Graded on the modified Davis scale, fundus photo — 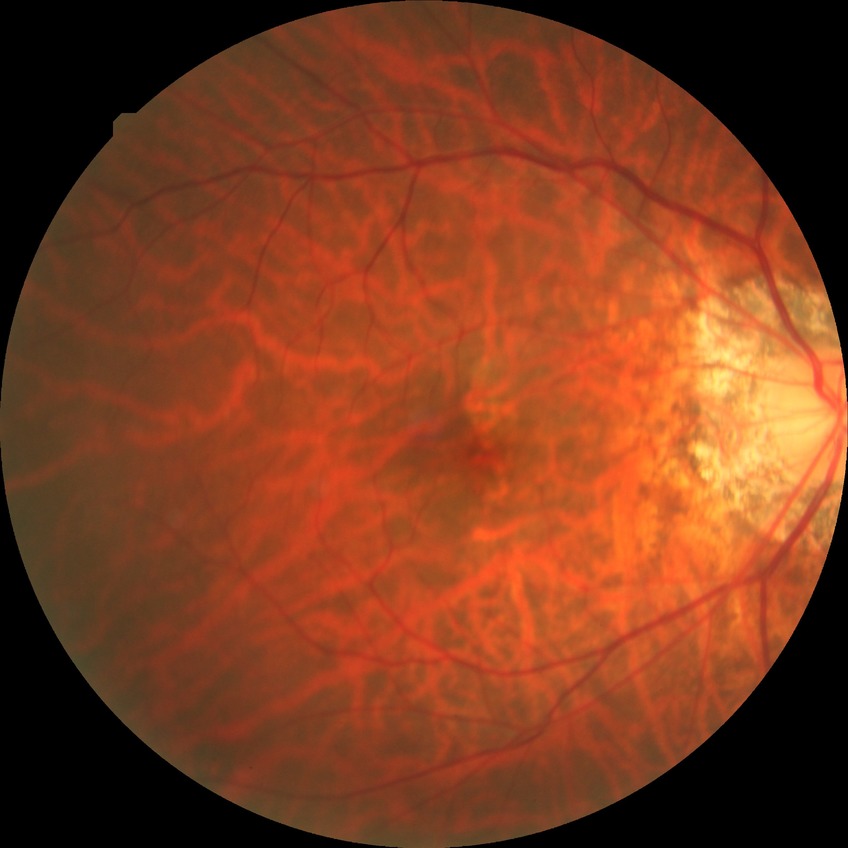

Modified Davis grading: no diabetic retinopathy.